Infant wide-field fundus photograph: 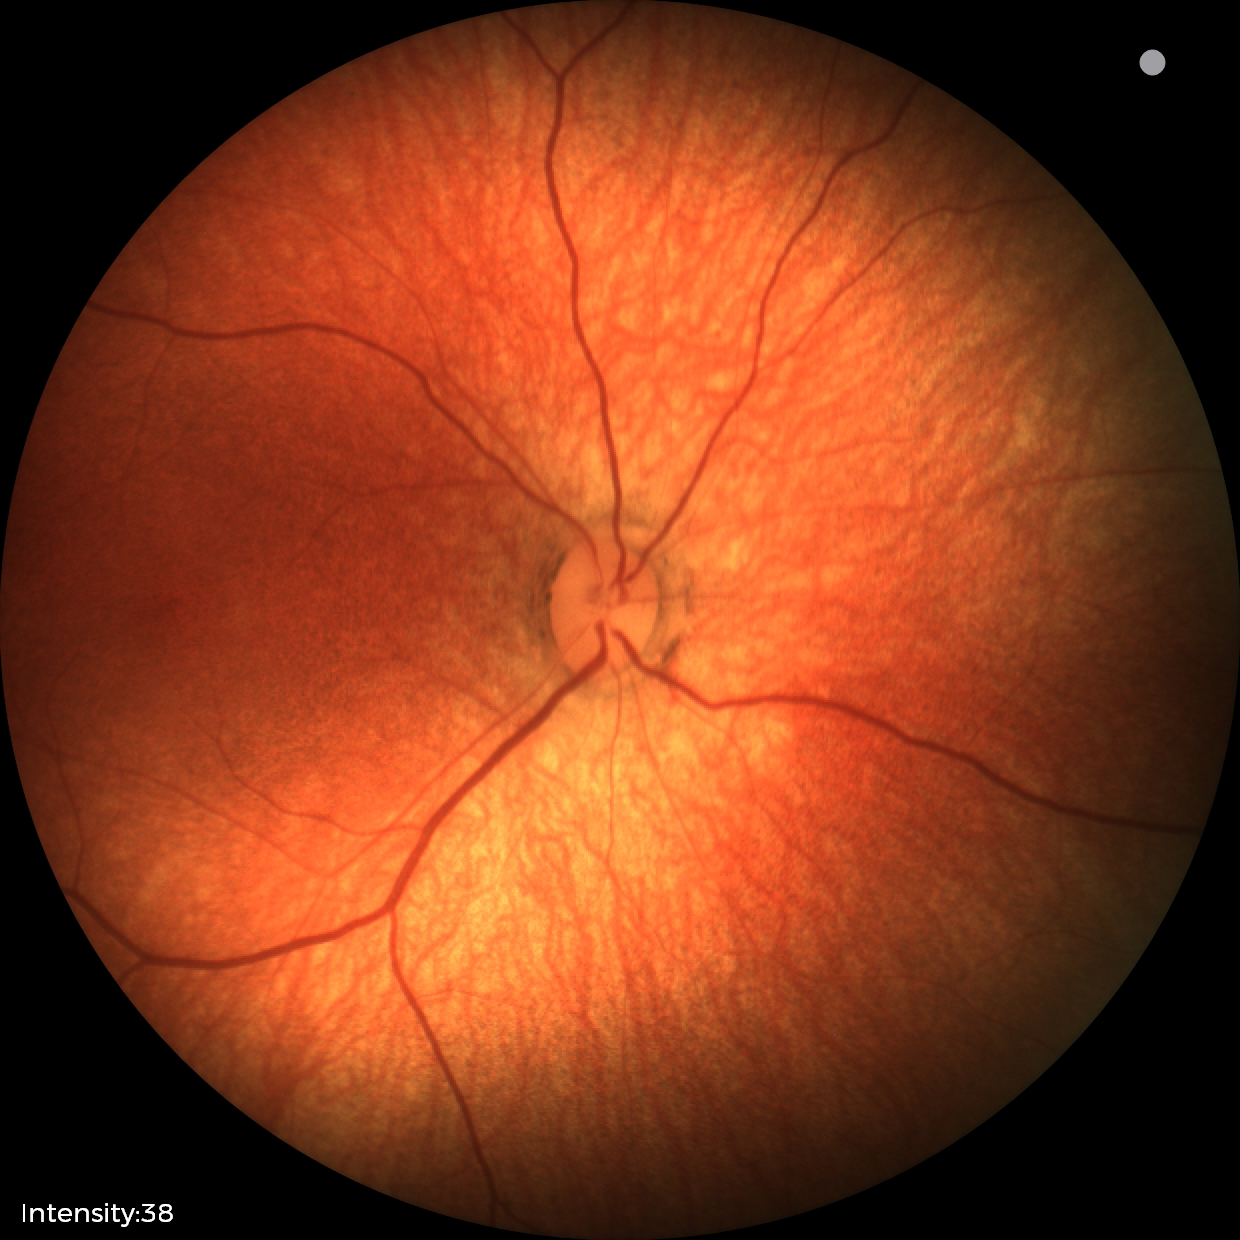

Screening examination diagnosed as physiological.